Image size 2089x1764 — 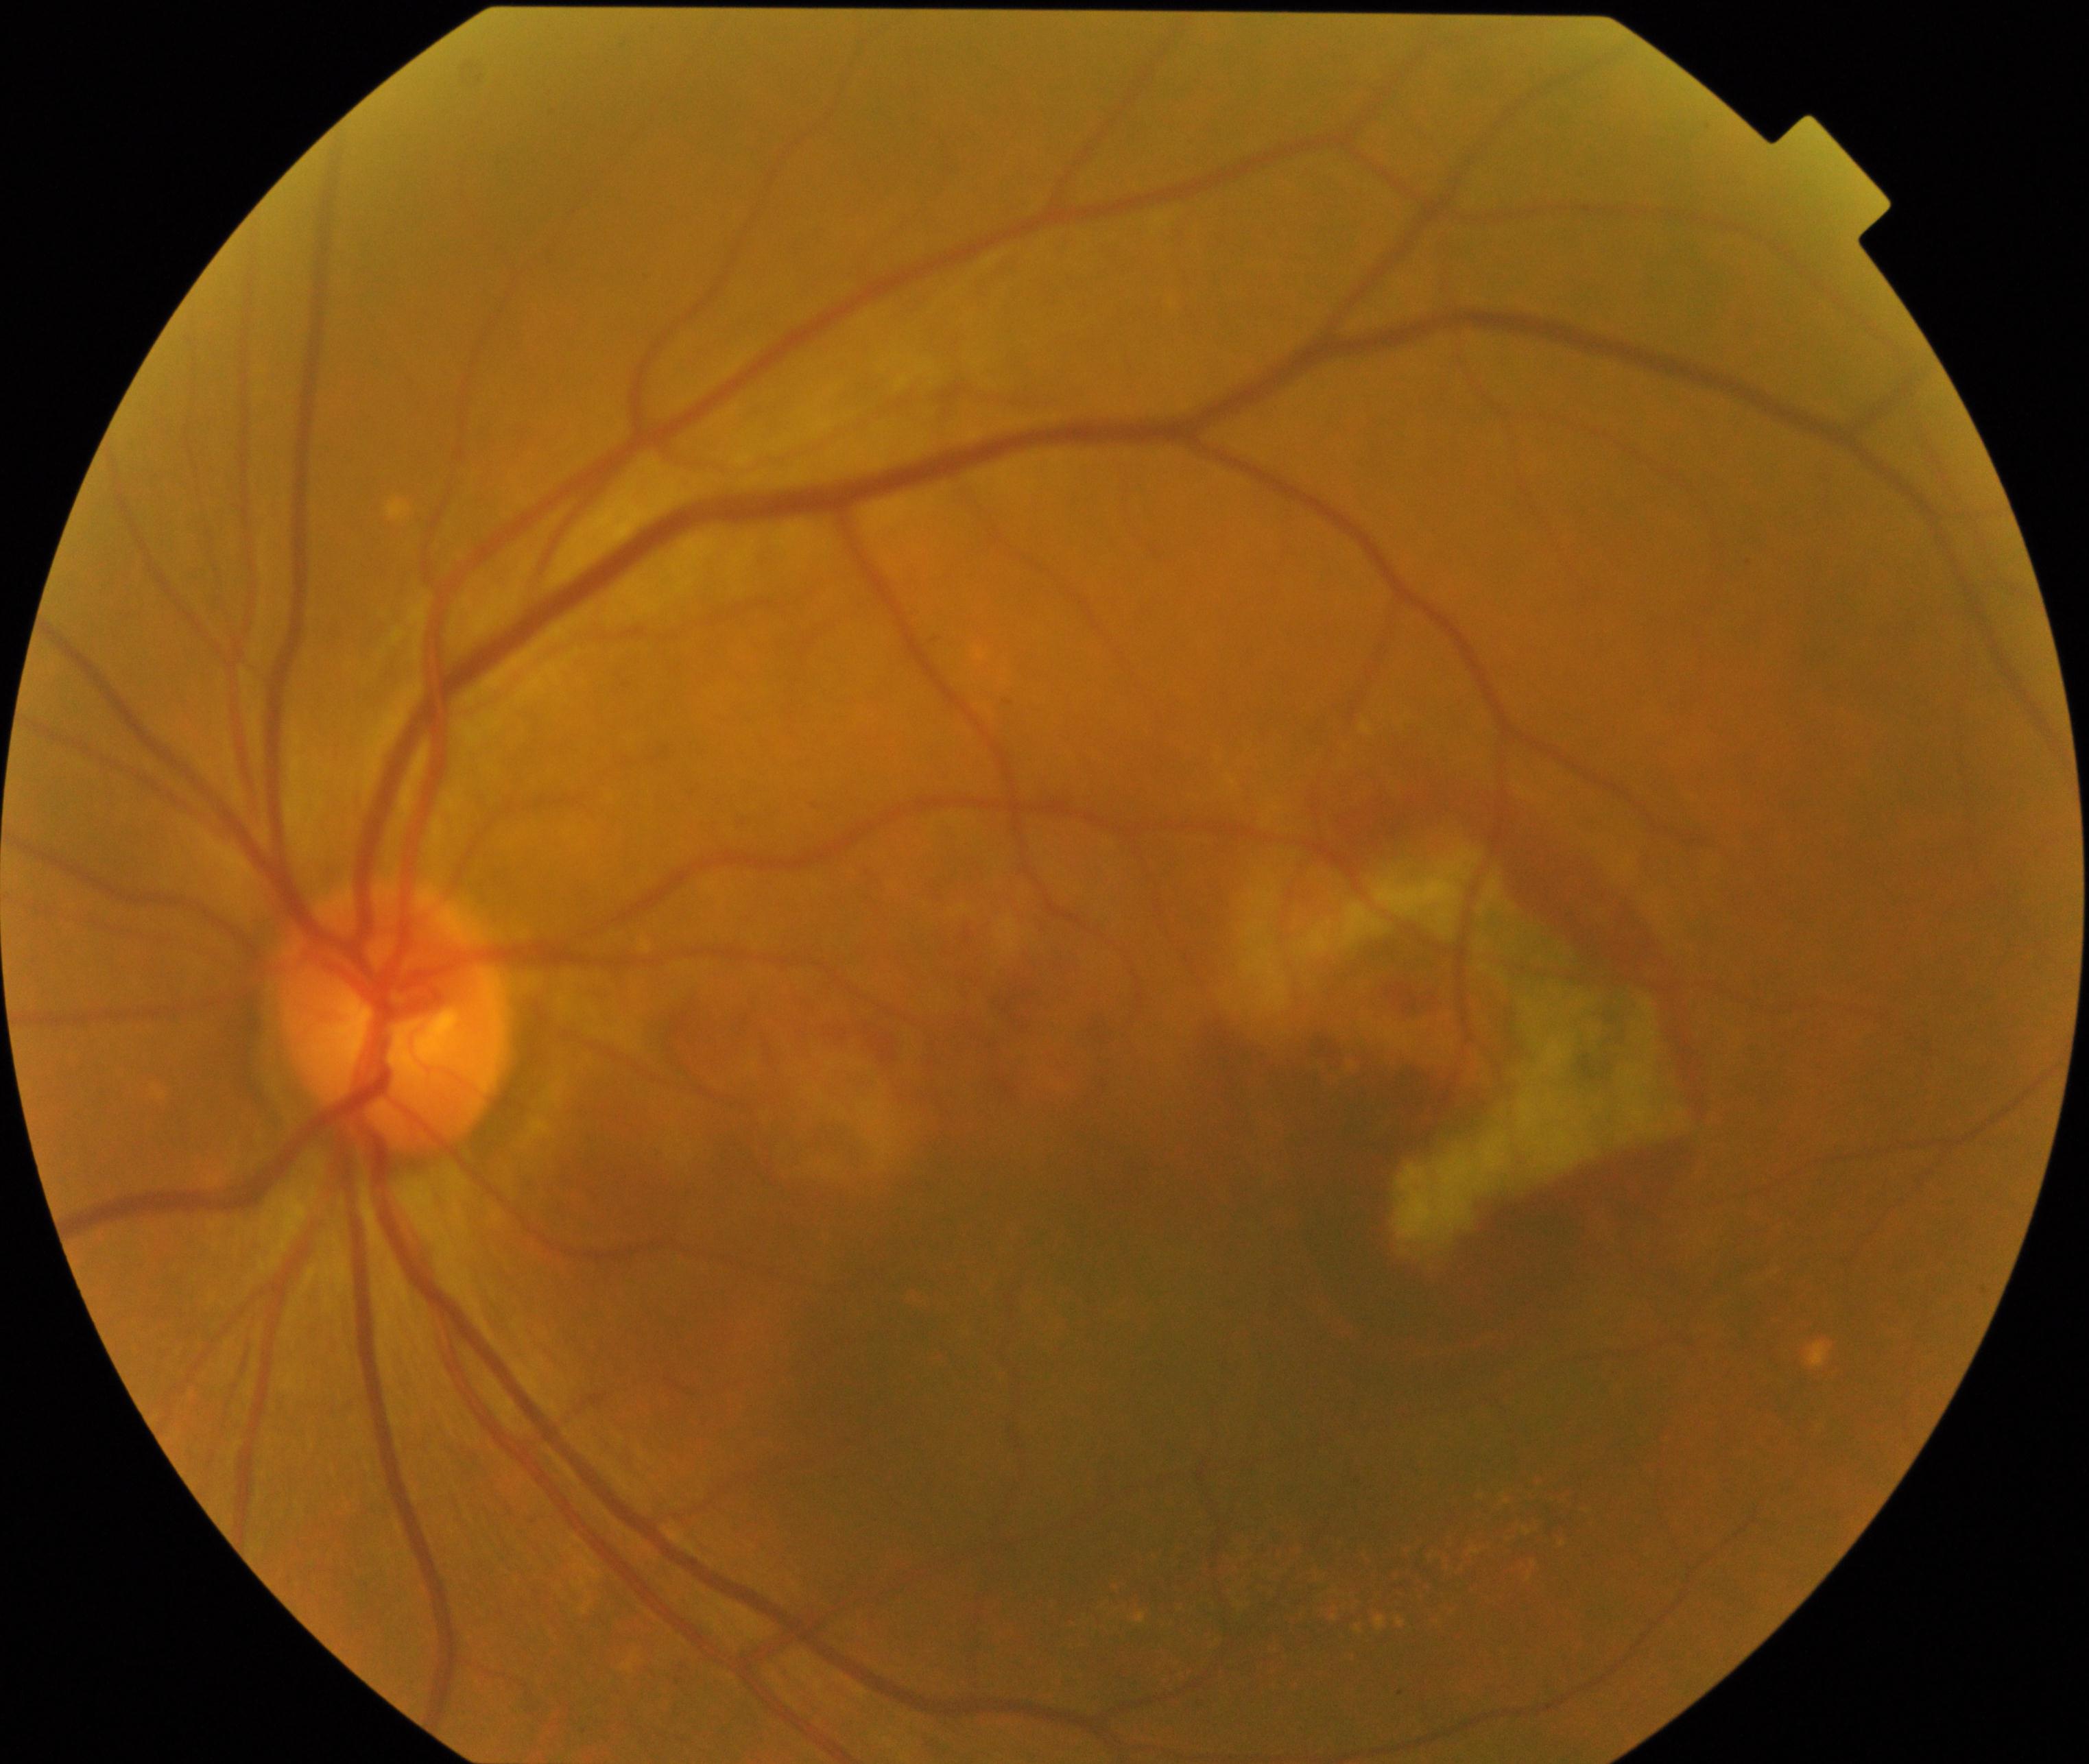

There is evidence of maculopathy.